45° field of view; graded on the modified Davis scale:
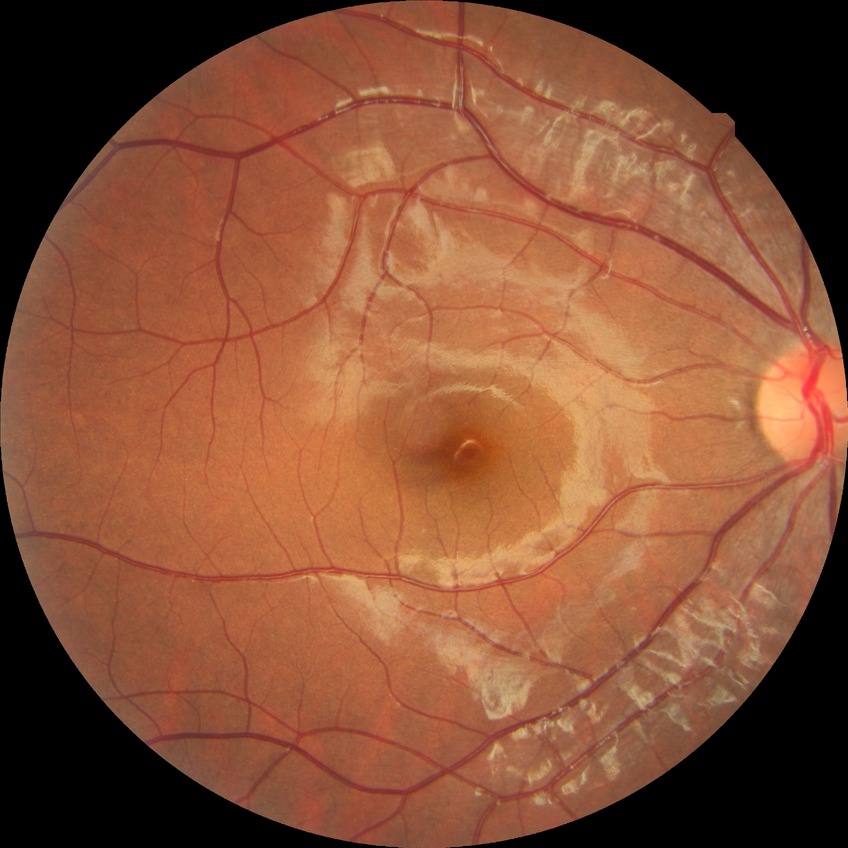
Diabetic retinopathy (DR): NDR (no diabetic retinopathy).